Wide-field fundus photograph of an infant — 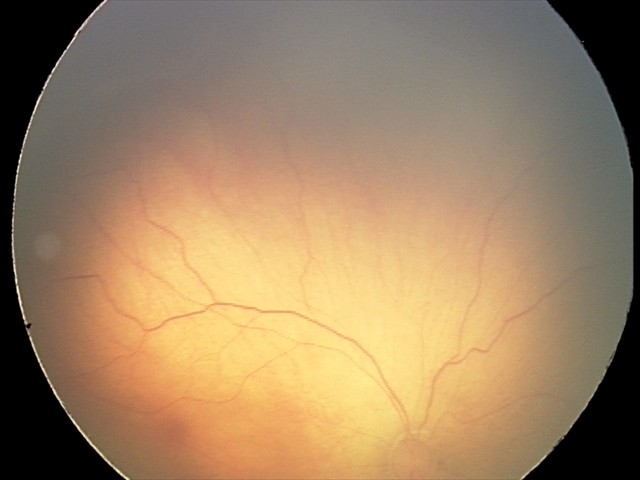
Screening series with ROP stage 2.
Plus disease absent.